1240x1240px. Wide-field fundus photograph from neonatal ROP screening
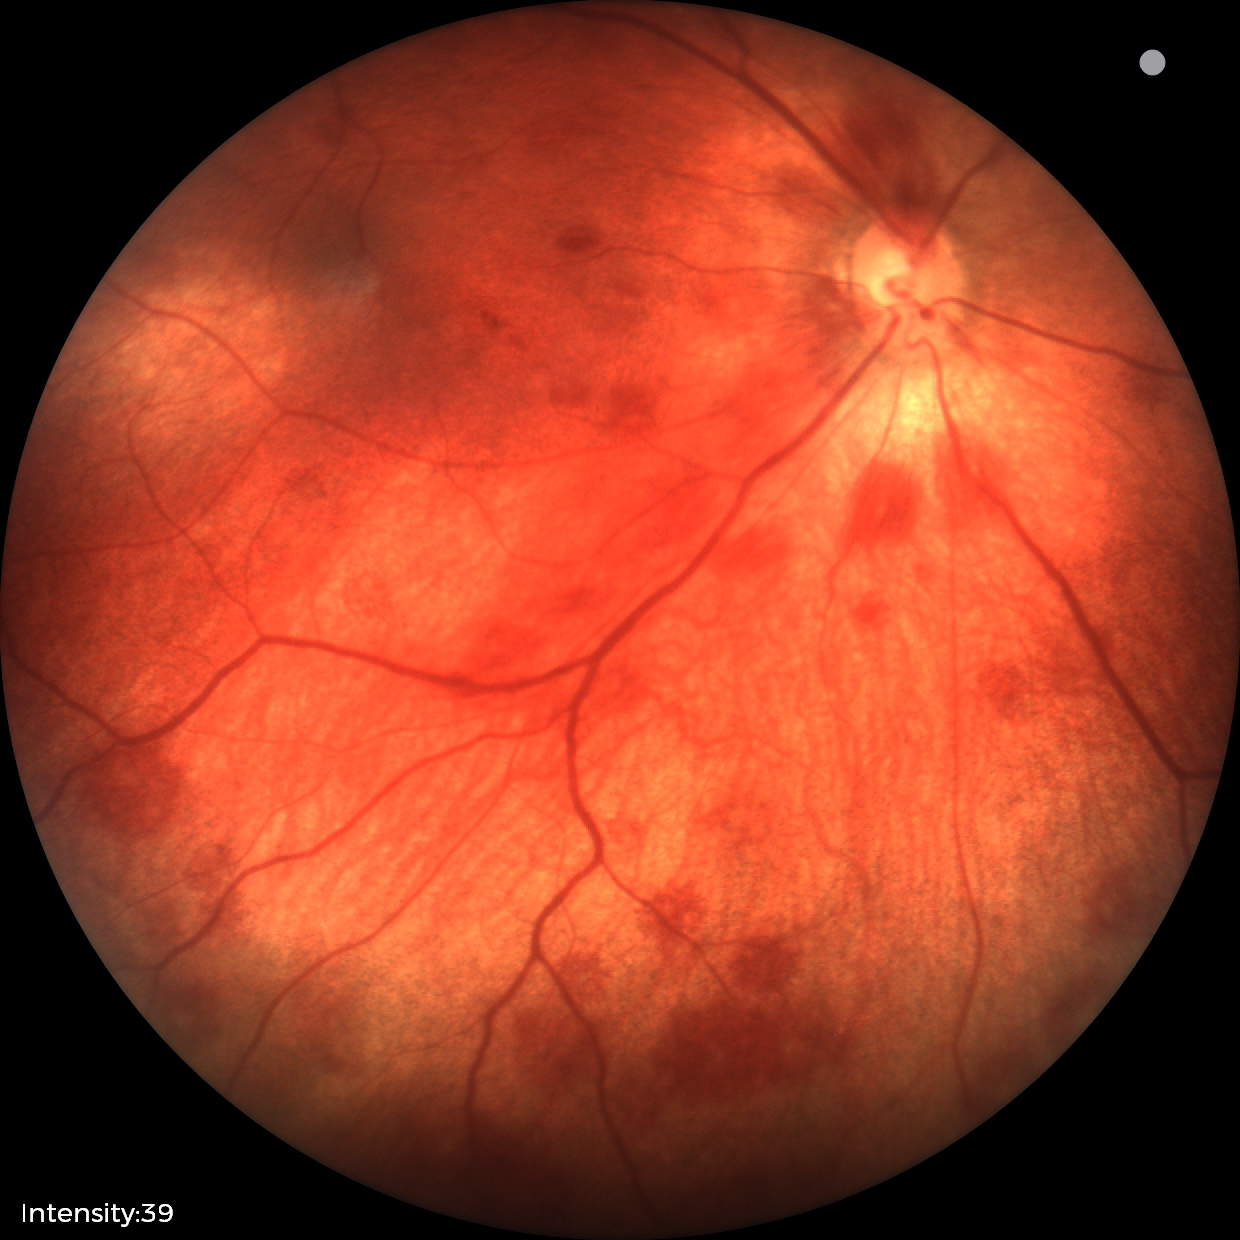 Impression: retinal hemorrhages.